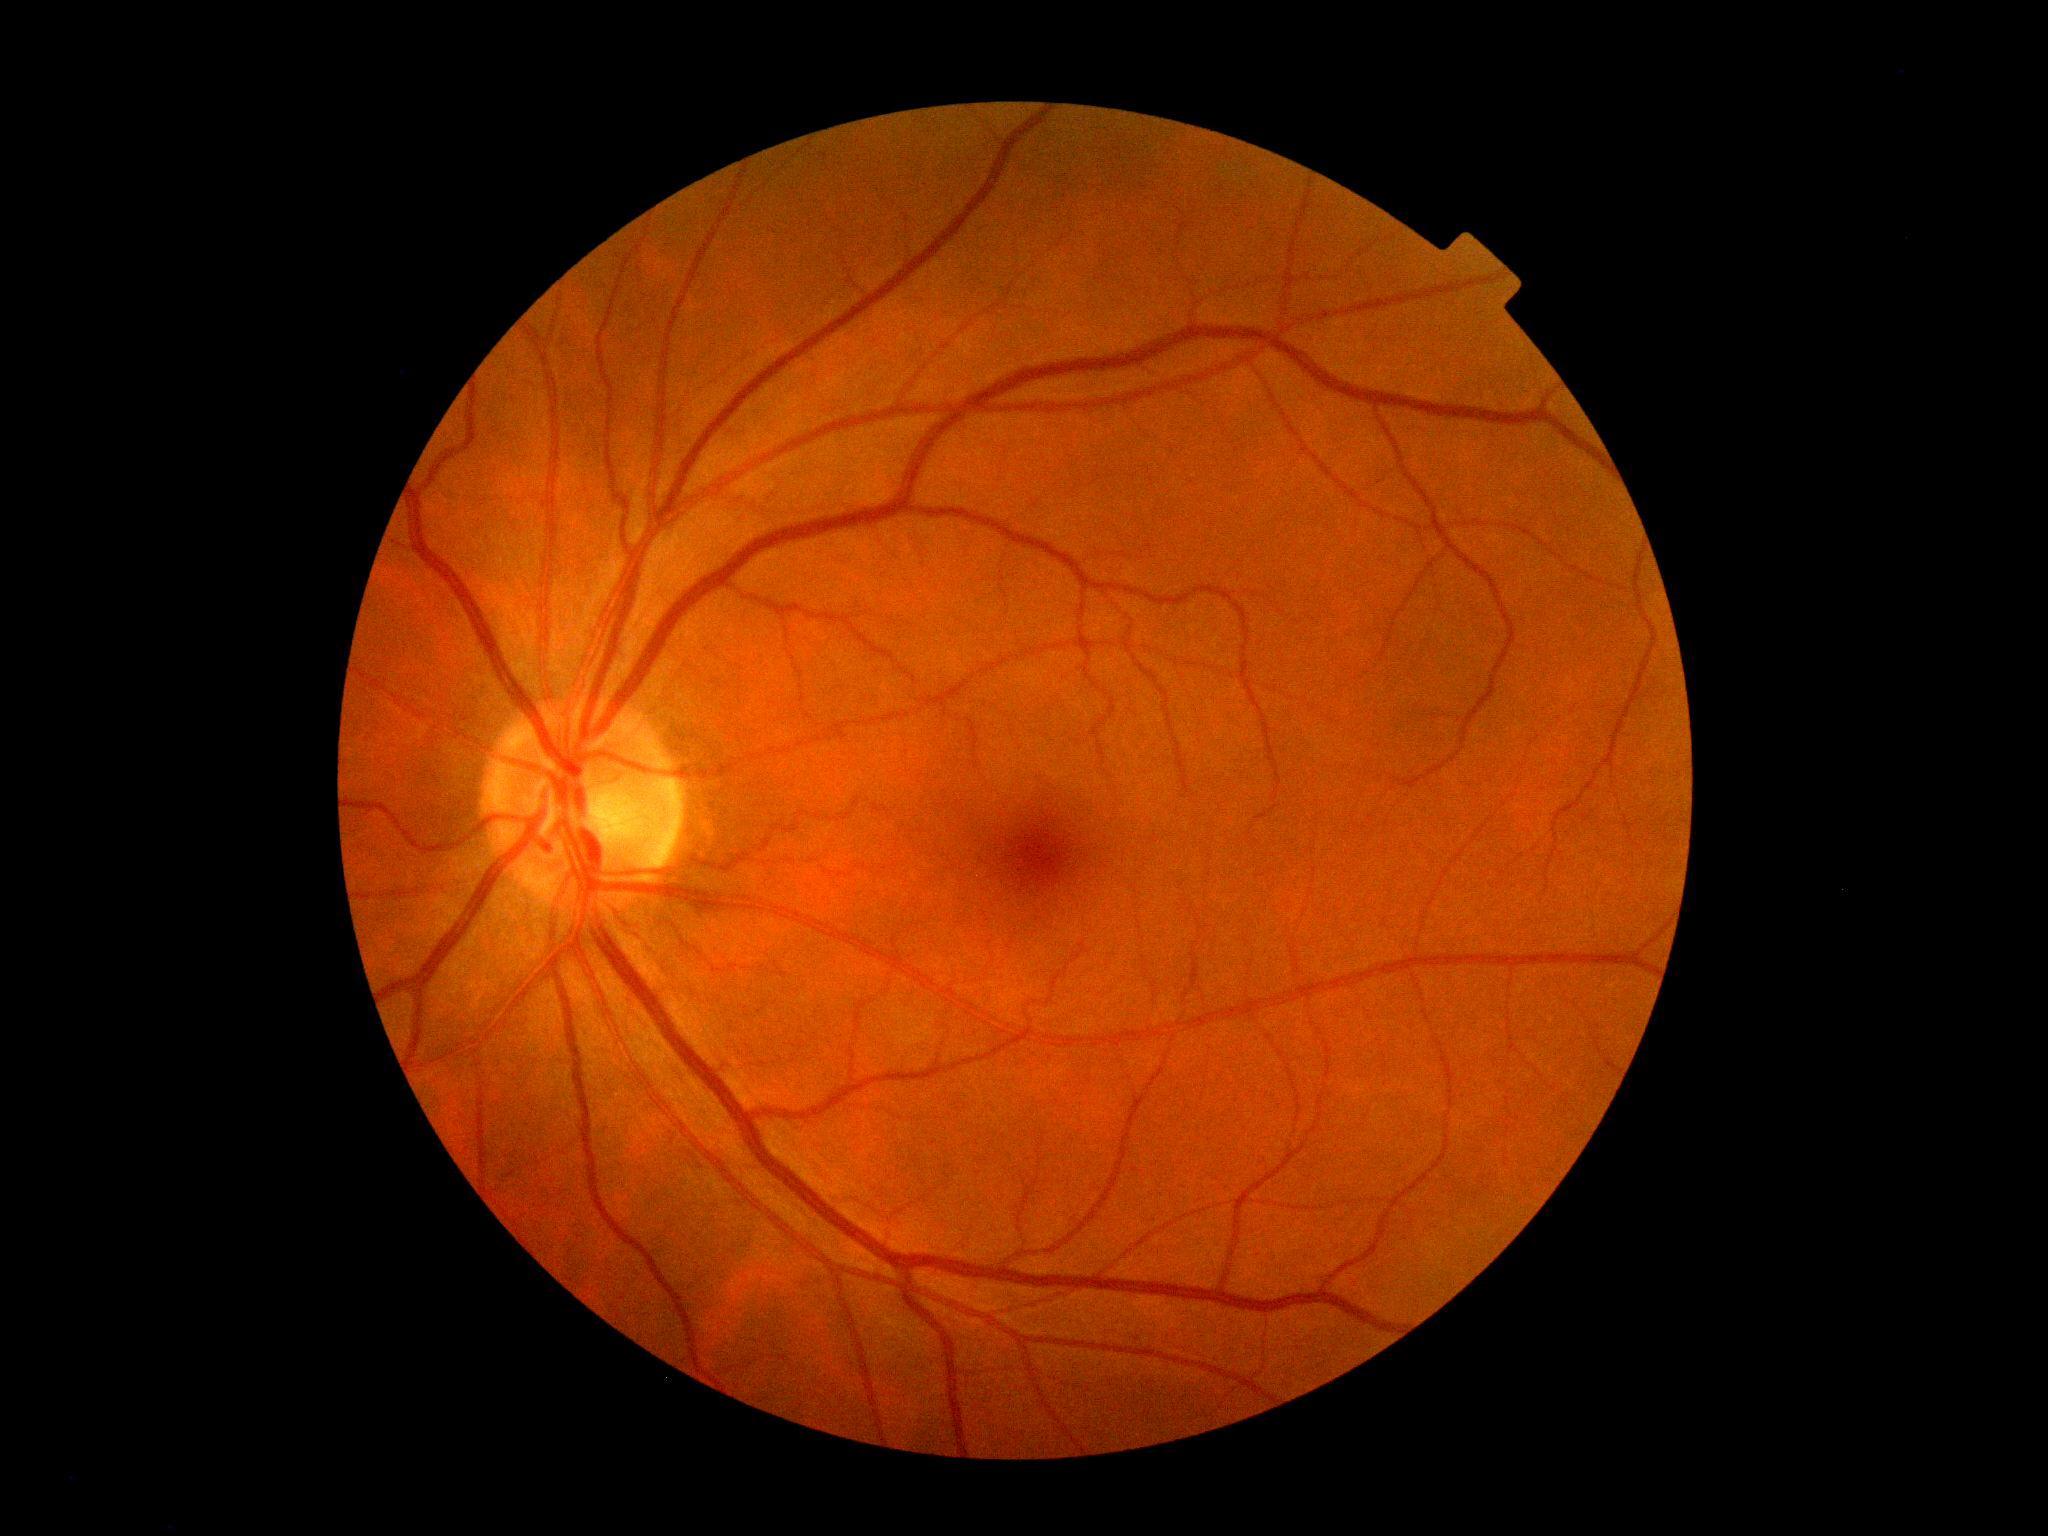 Diabetic retinopathy is 0 — no visible signs of diabetic retinopathy.